Infant wide-field fundus photograph: 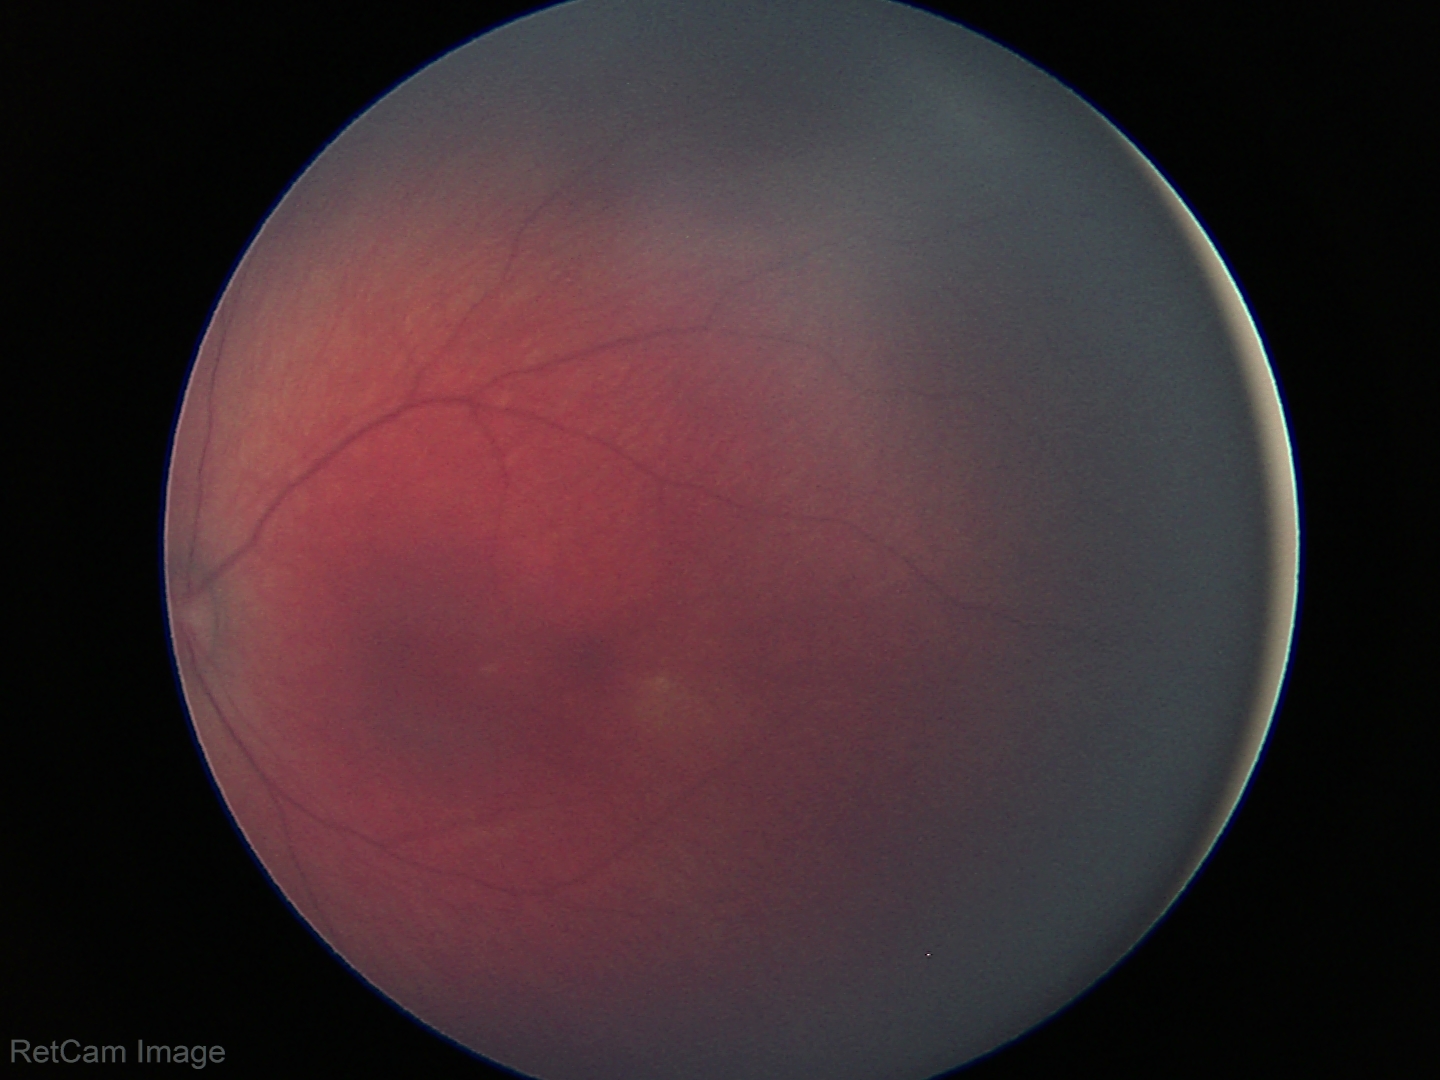
Screening examination with no abnormal retinal findings.